848x848 · without pupil dilation.
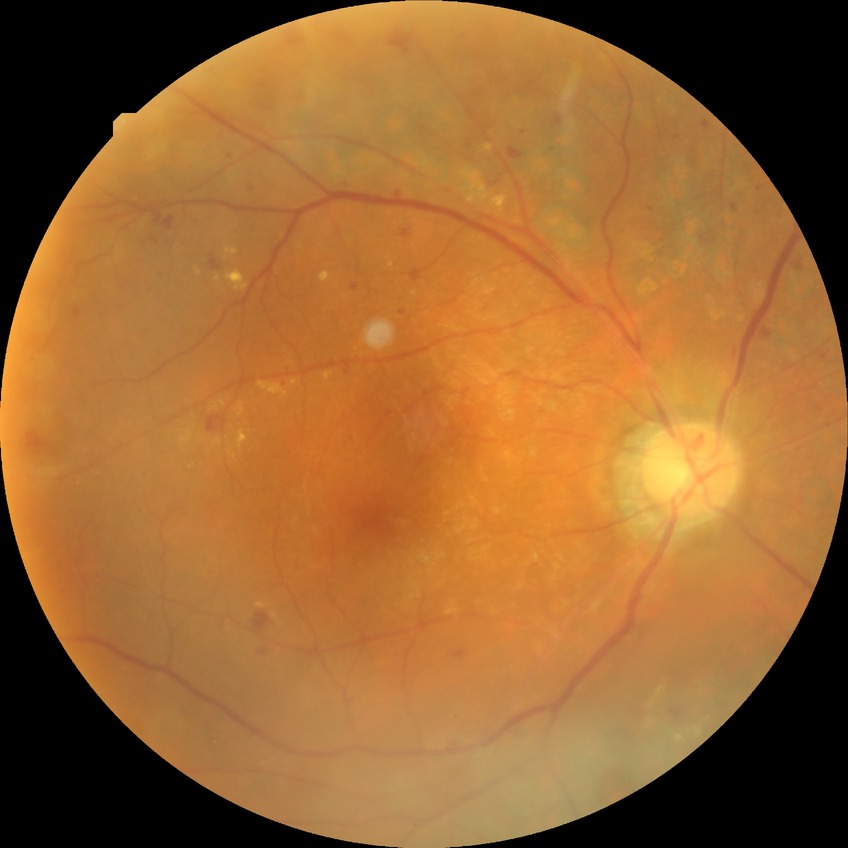

diabetic retinopathy (DR): PDR (proliferative diabetic retinopathy).